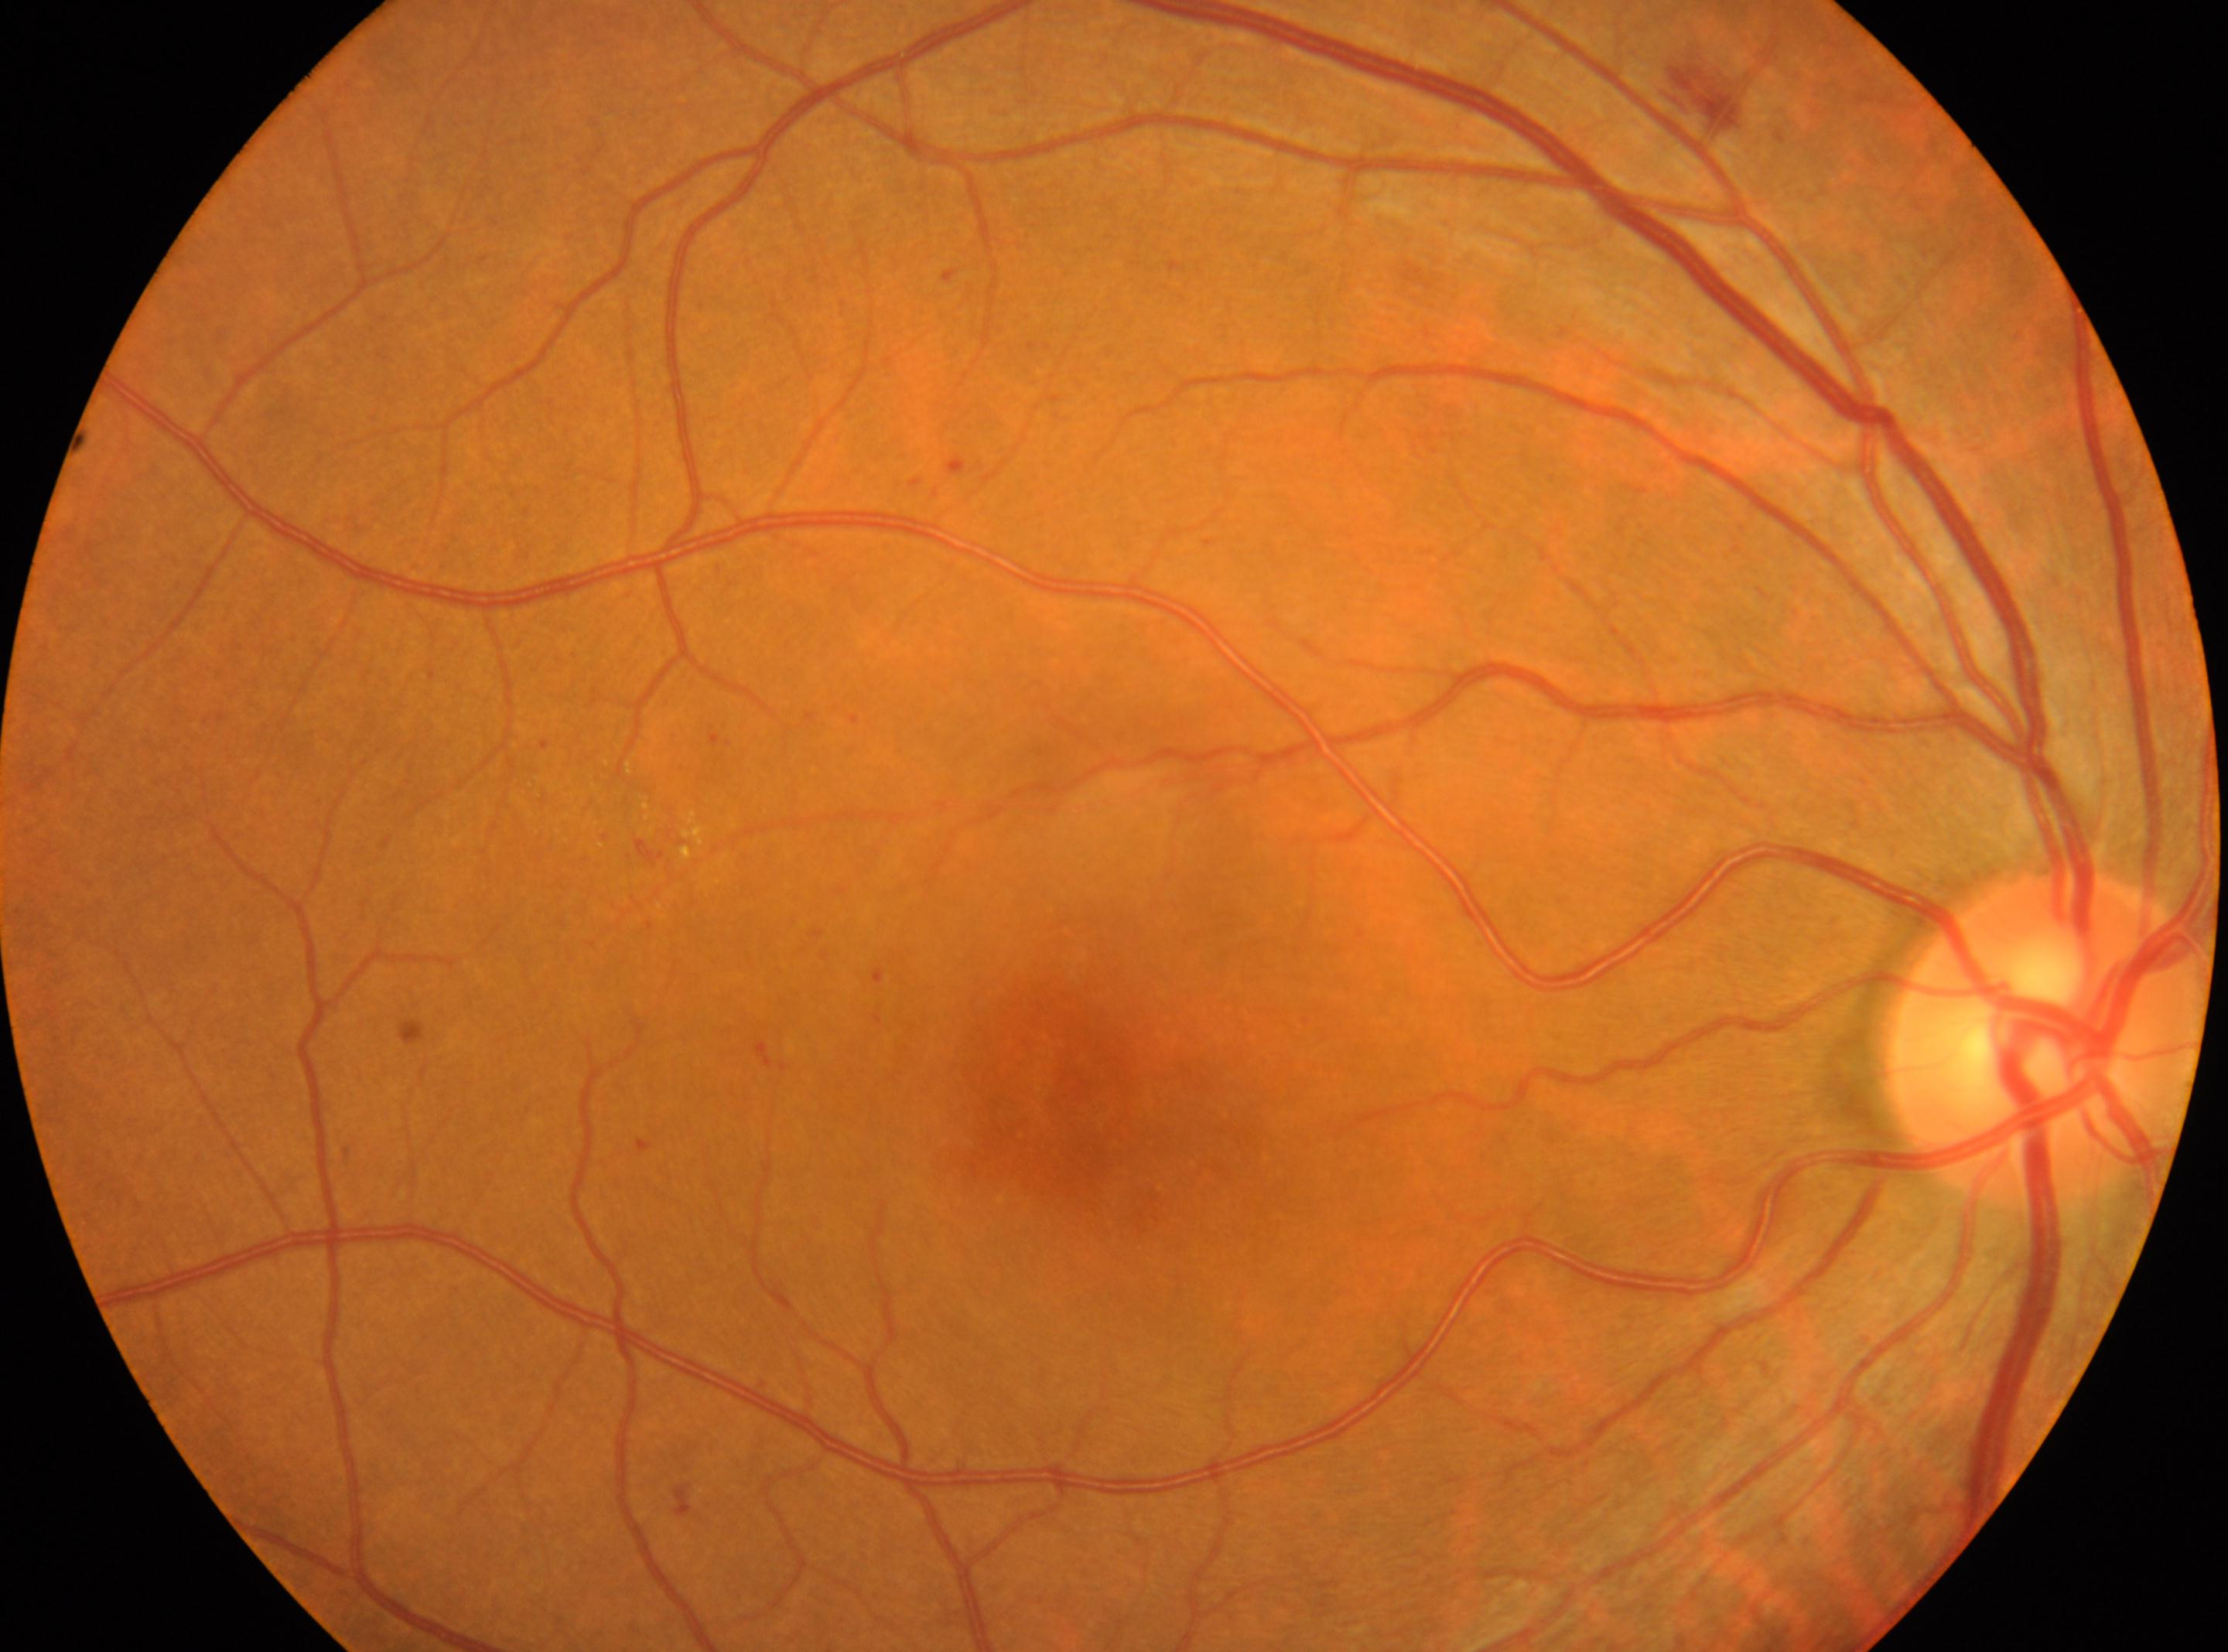

DR severity: moderate NPDR (grade 2).
The optic disk is at [2049, 1036].
The fovea center is at [1066, 1108].
Imaged eye: oculus dexter.